Color fundus photograph. 741x709. 45° field of view.
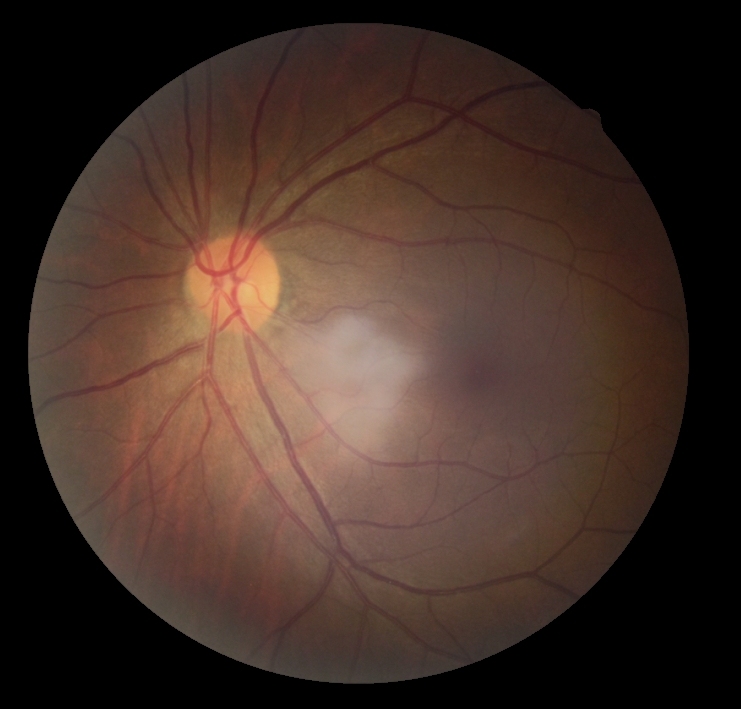 Diabetic retinopathy (DR) is 0.
No diabetic retinal disease findings.